Modified Davis grading. 45° FOV: 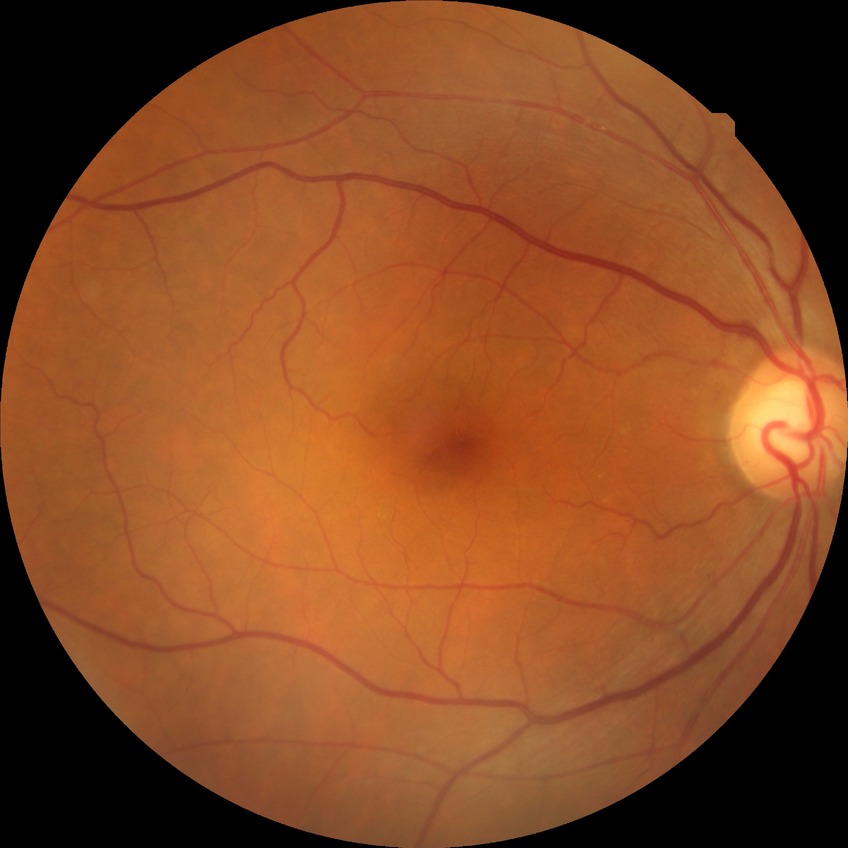
Diabetic retinopathy stage is no diabetic retinopathy.